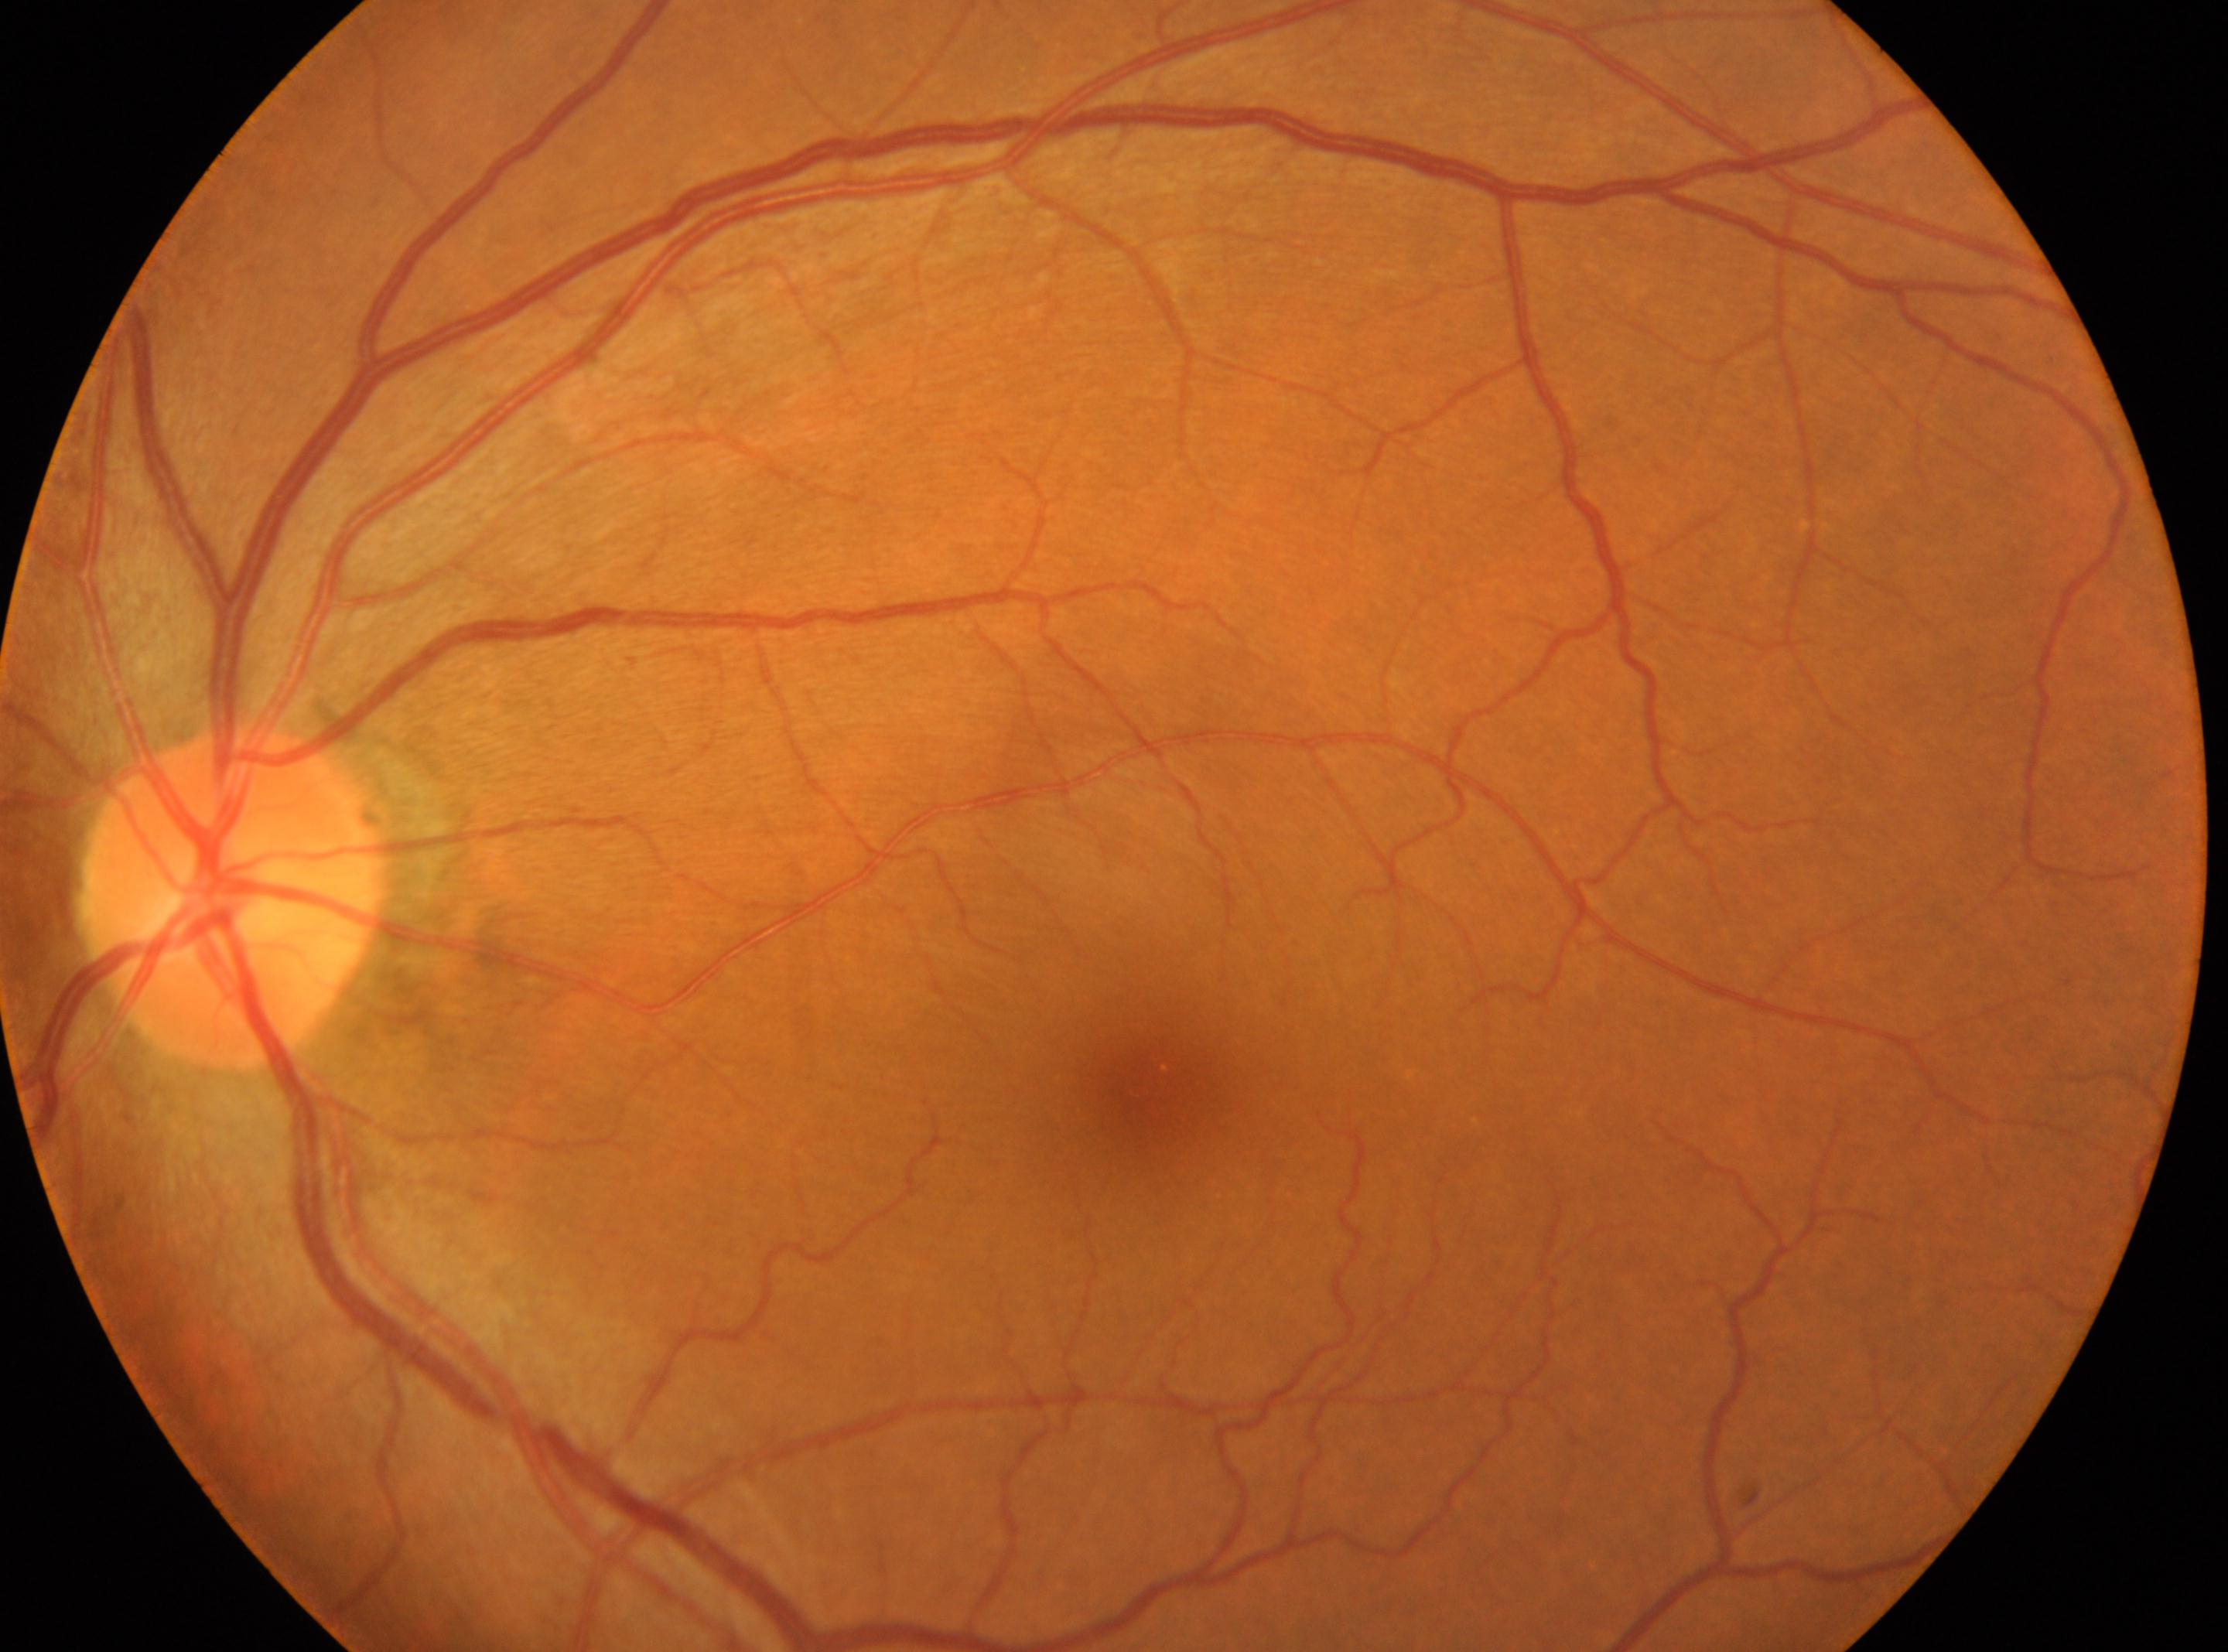

Diabetic retinopathy (DR) is 0/4.
Eye: left.
No diabetic retinal disease findings.
Macular center located at x=1142, y=1087.
Optic disc located at x=236, y=897.